Posterior pole color fundus photograph; diabetic retinopathy graded by the modified Davis classification; no pharmacologic dilation
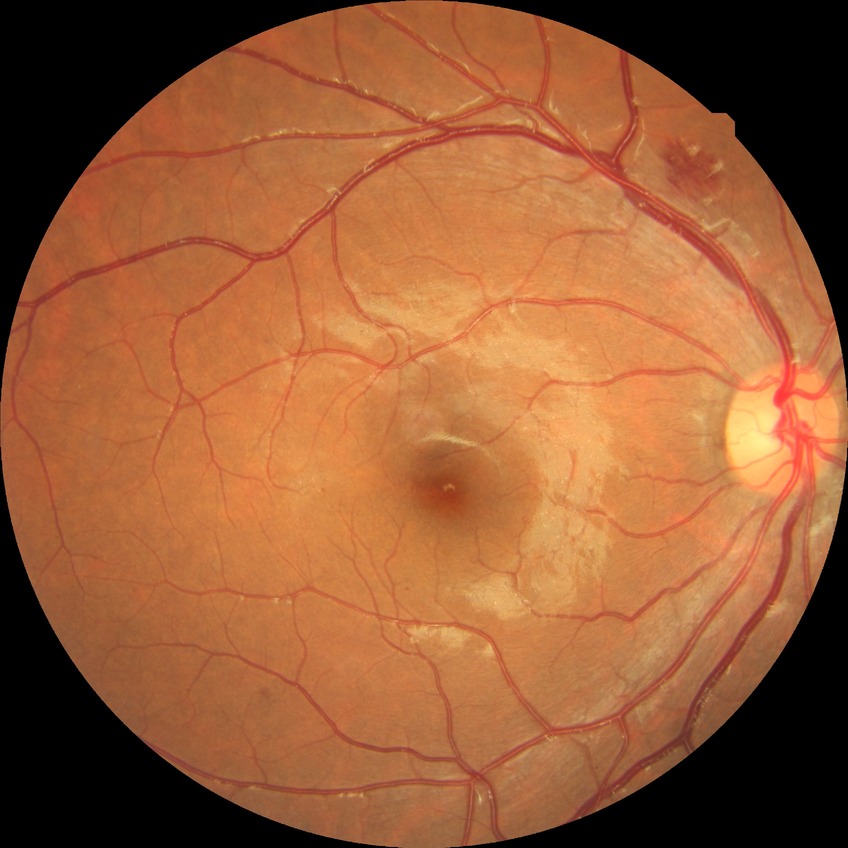 Diabetic retinopathy (DR): simple diabetic retinopathy (SDR). The retinopathy is classified as non-proliferative diabetic retinopathy.